Acquired with a NIDEK AFC-230, 848x848px, fundus photo — 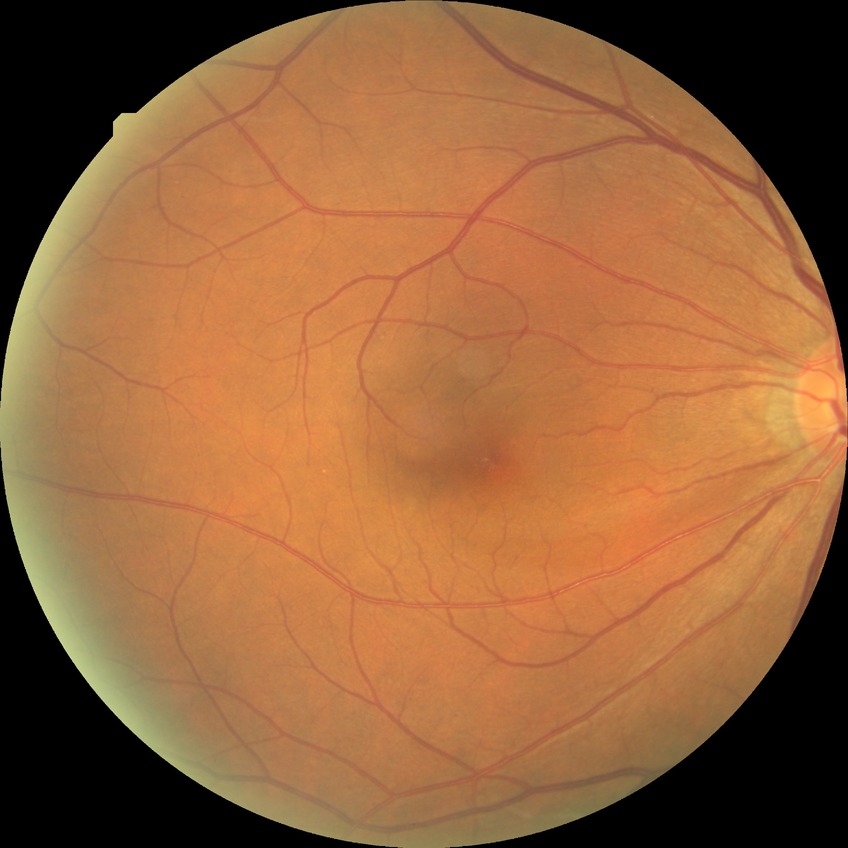

{"davis_grade": "no diabetic retinopathy"}